1932x1916px · 45° FOV
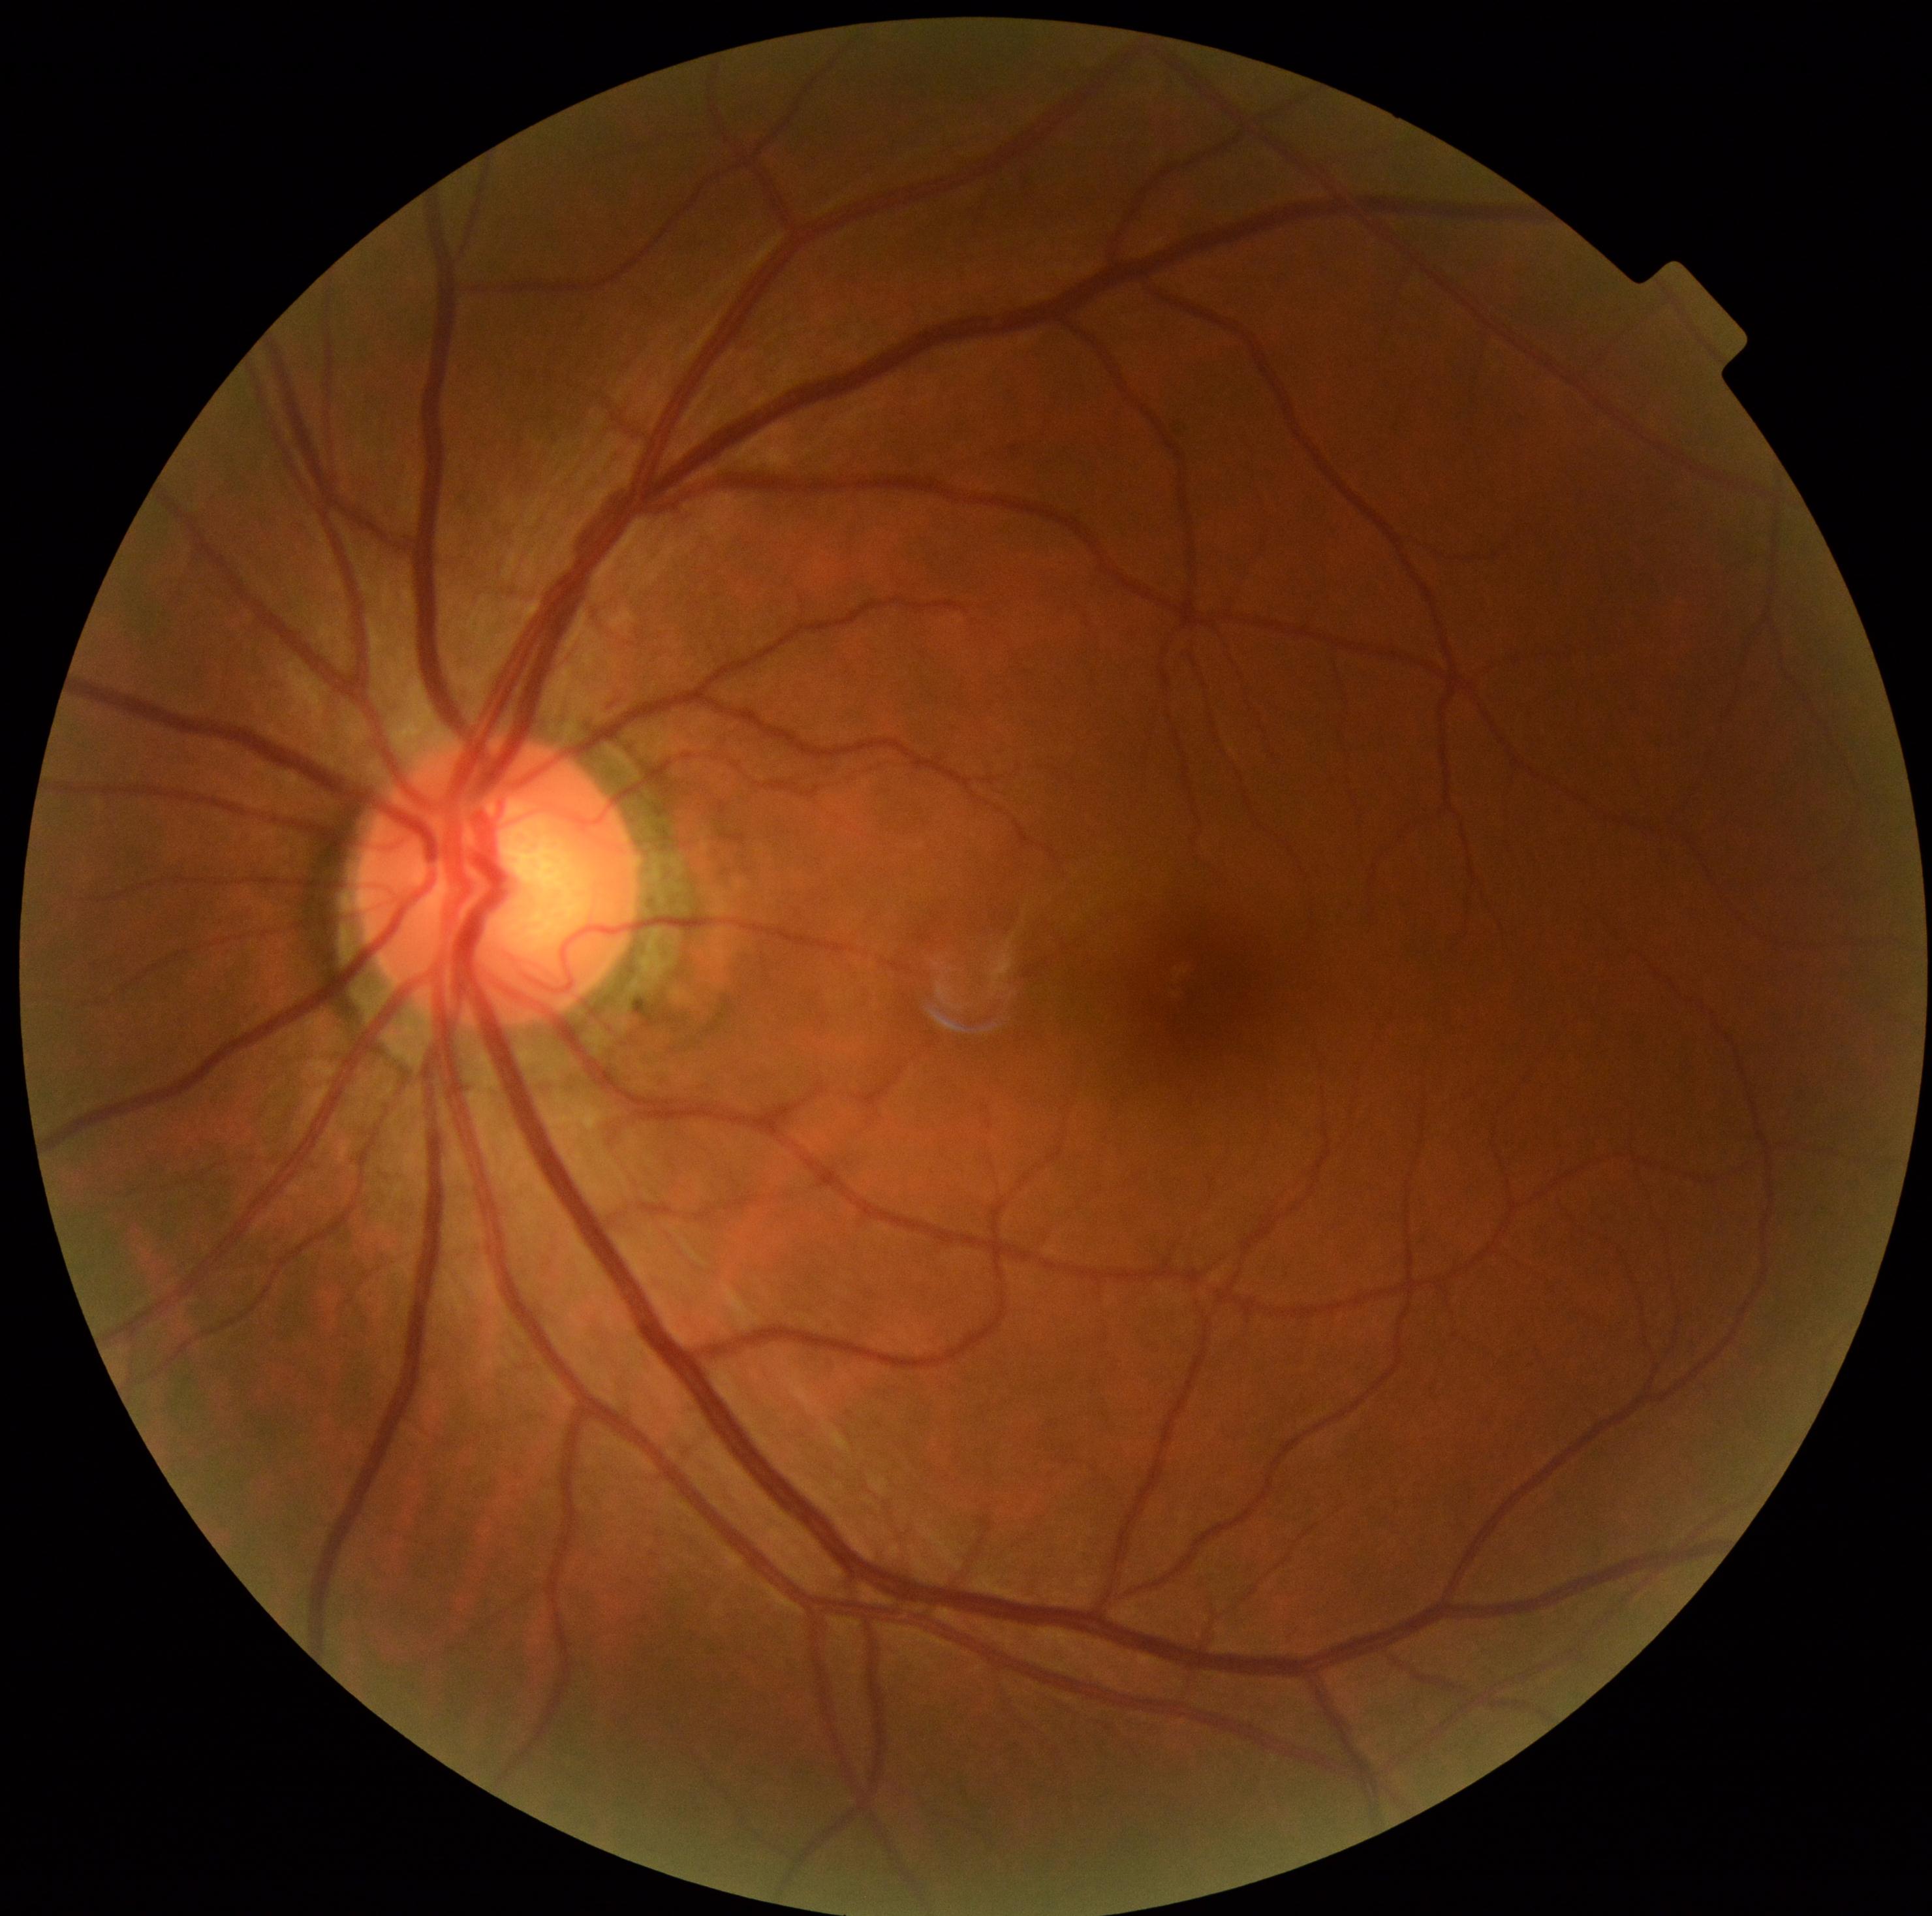
diabetic retinopathy grade: 0/4